2352x1568px: 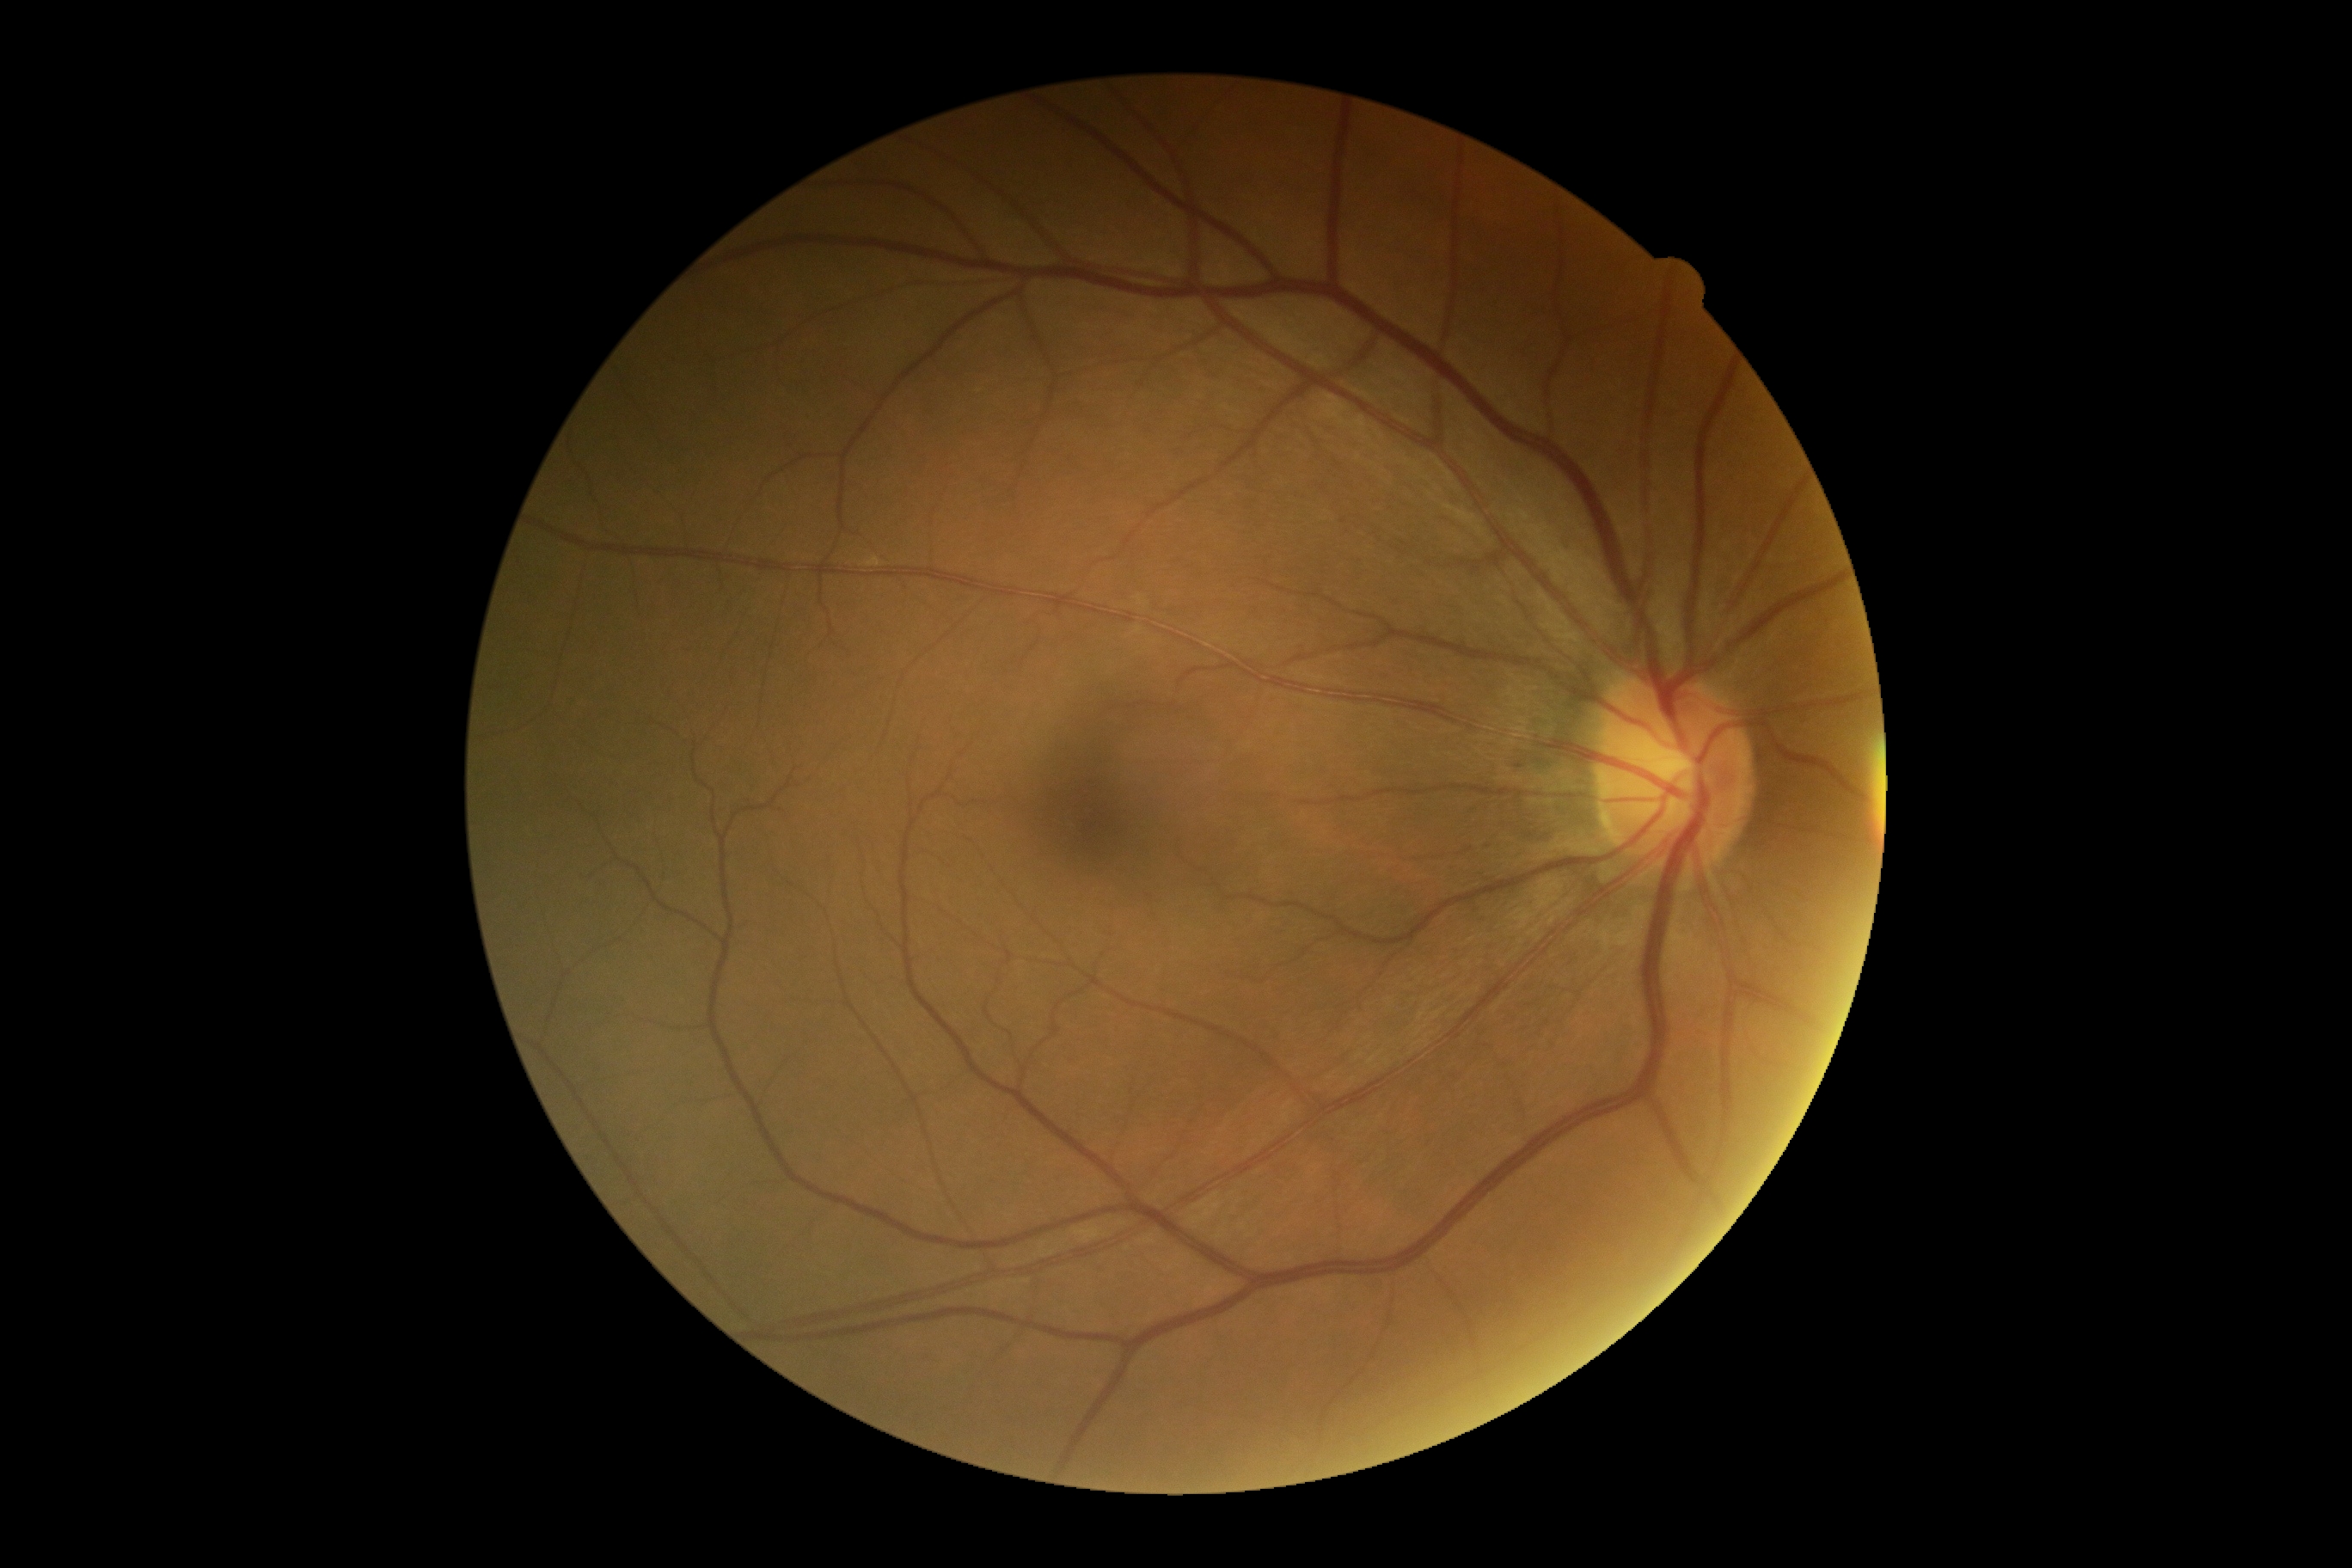 No DR findings.
DR is grade 0.